Wide-field fundus photograph from neonatal ROP screening.
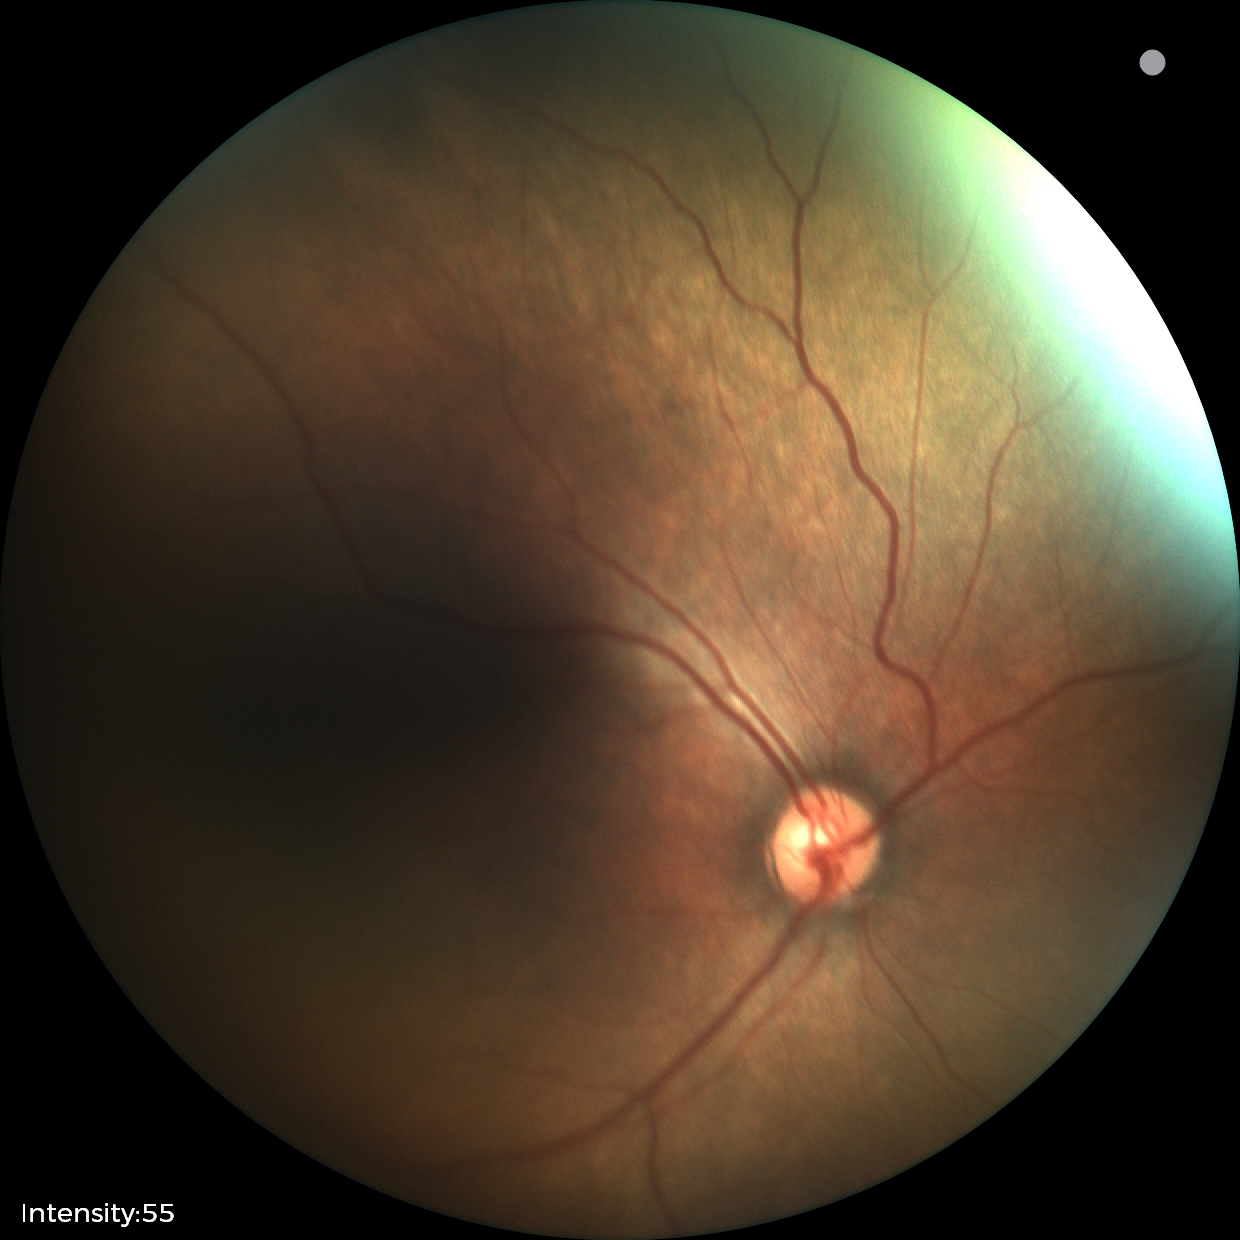

Plus disease absent. Screening series with status post retinopathy of prematurity.